Posterior pole color fundus photograph, without pupil dilation, 848x848px, 45° FOV, acquired with a NIDEK AFC-230
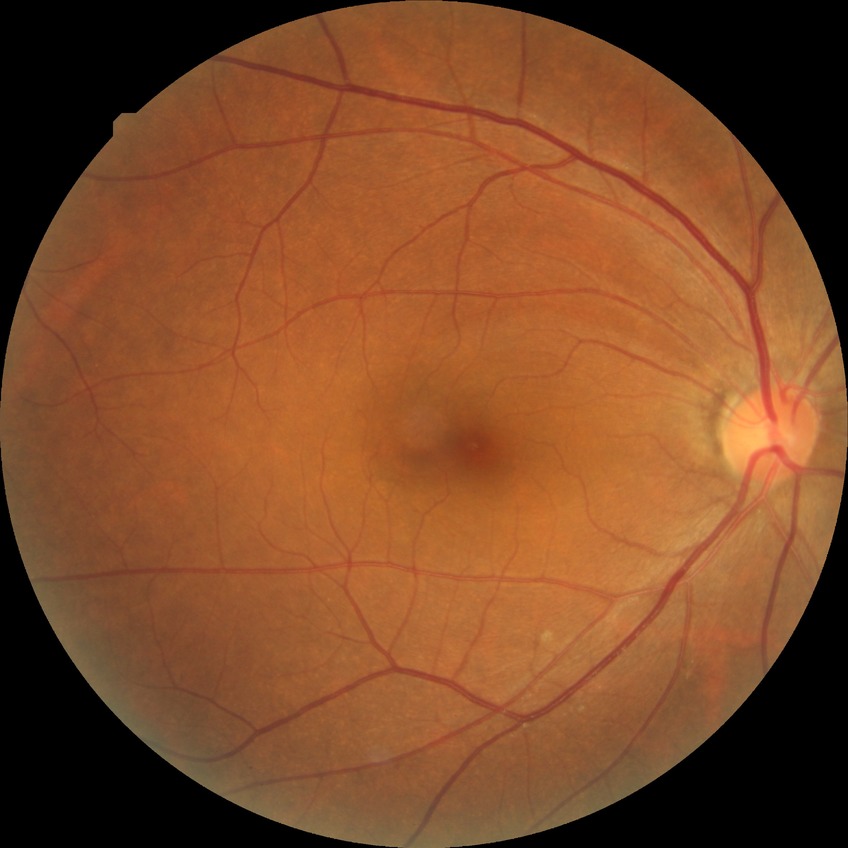 Diabetic retinopathy (DR): no diabetic retinopathy (NDR).